2184x1690:
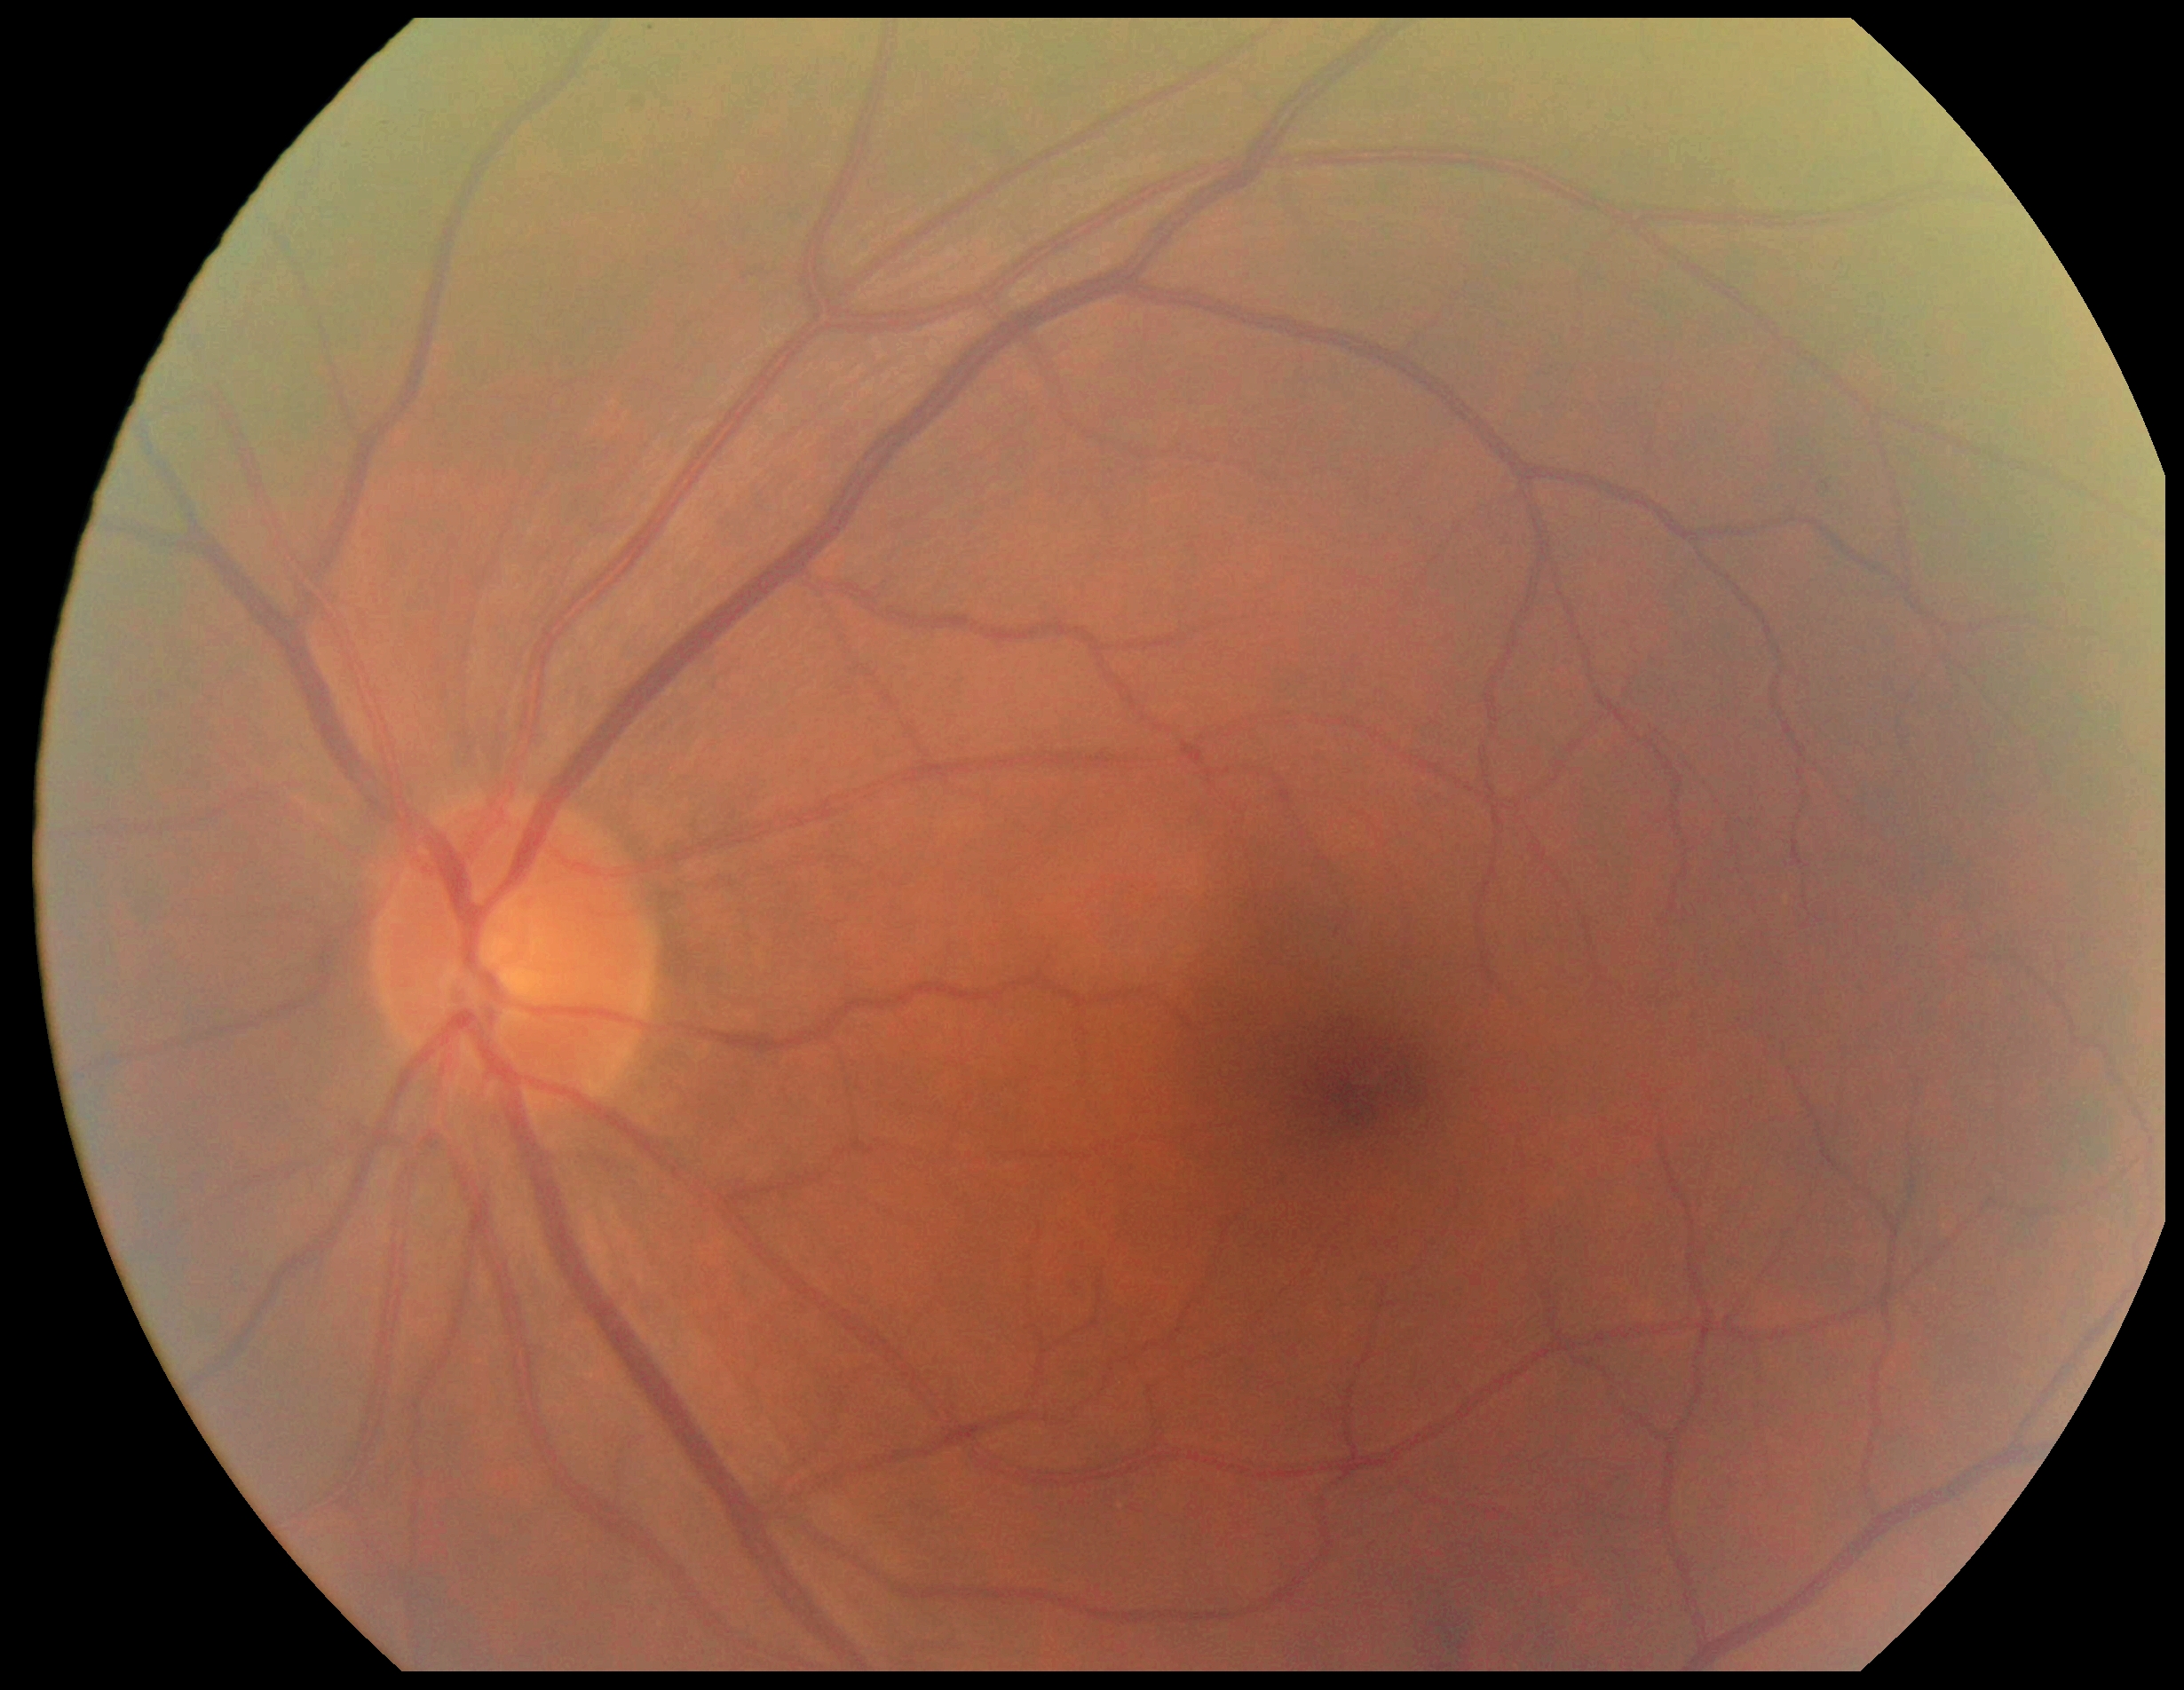

DR severity is no apparent diabetic retinopathy (grade 0). No signs of diabetic retinopathy.